45° field of view · 2352x1568 · color fundus photograph.
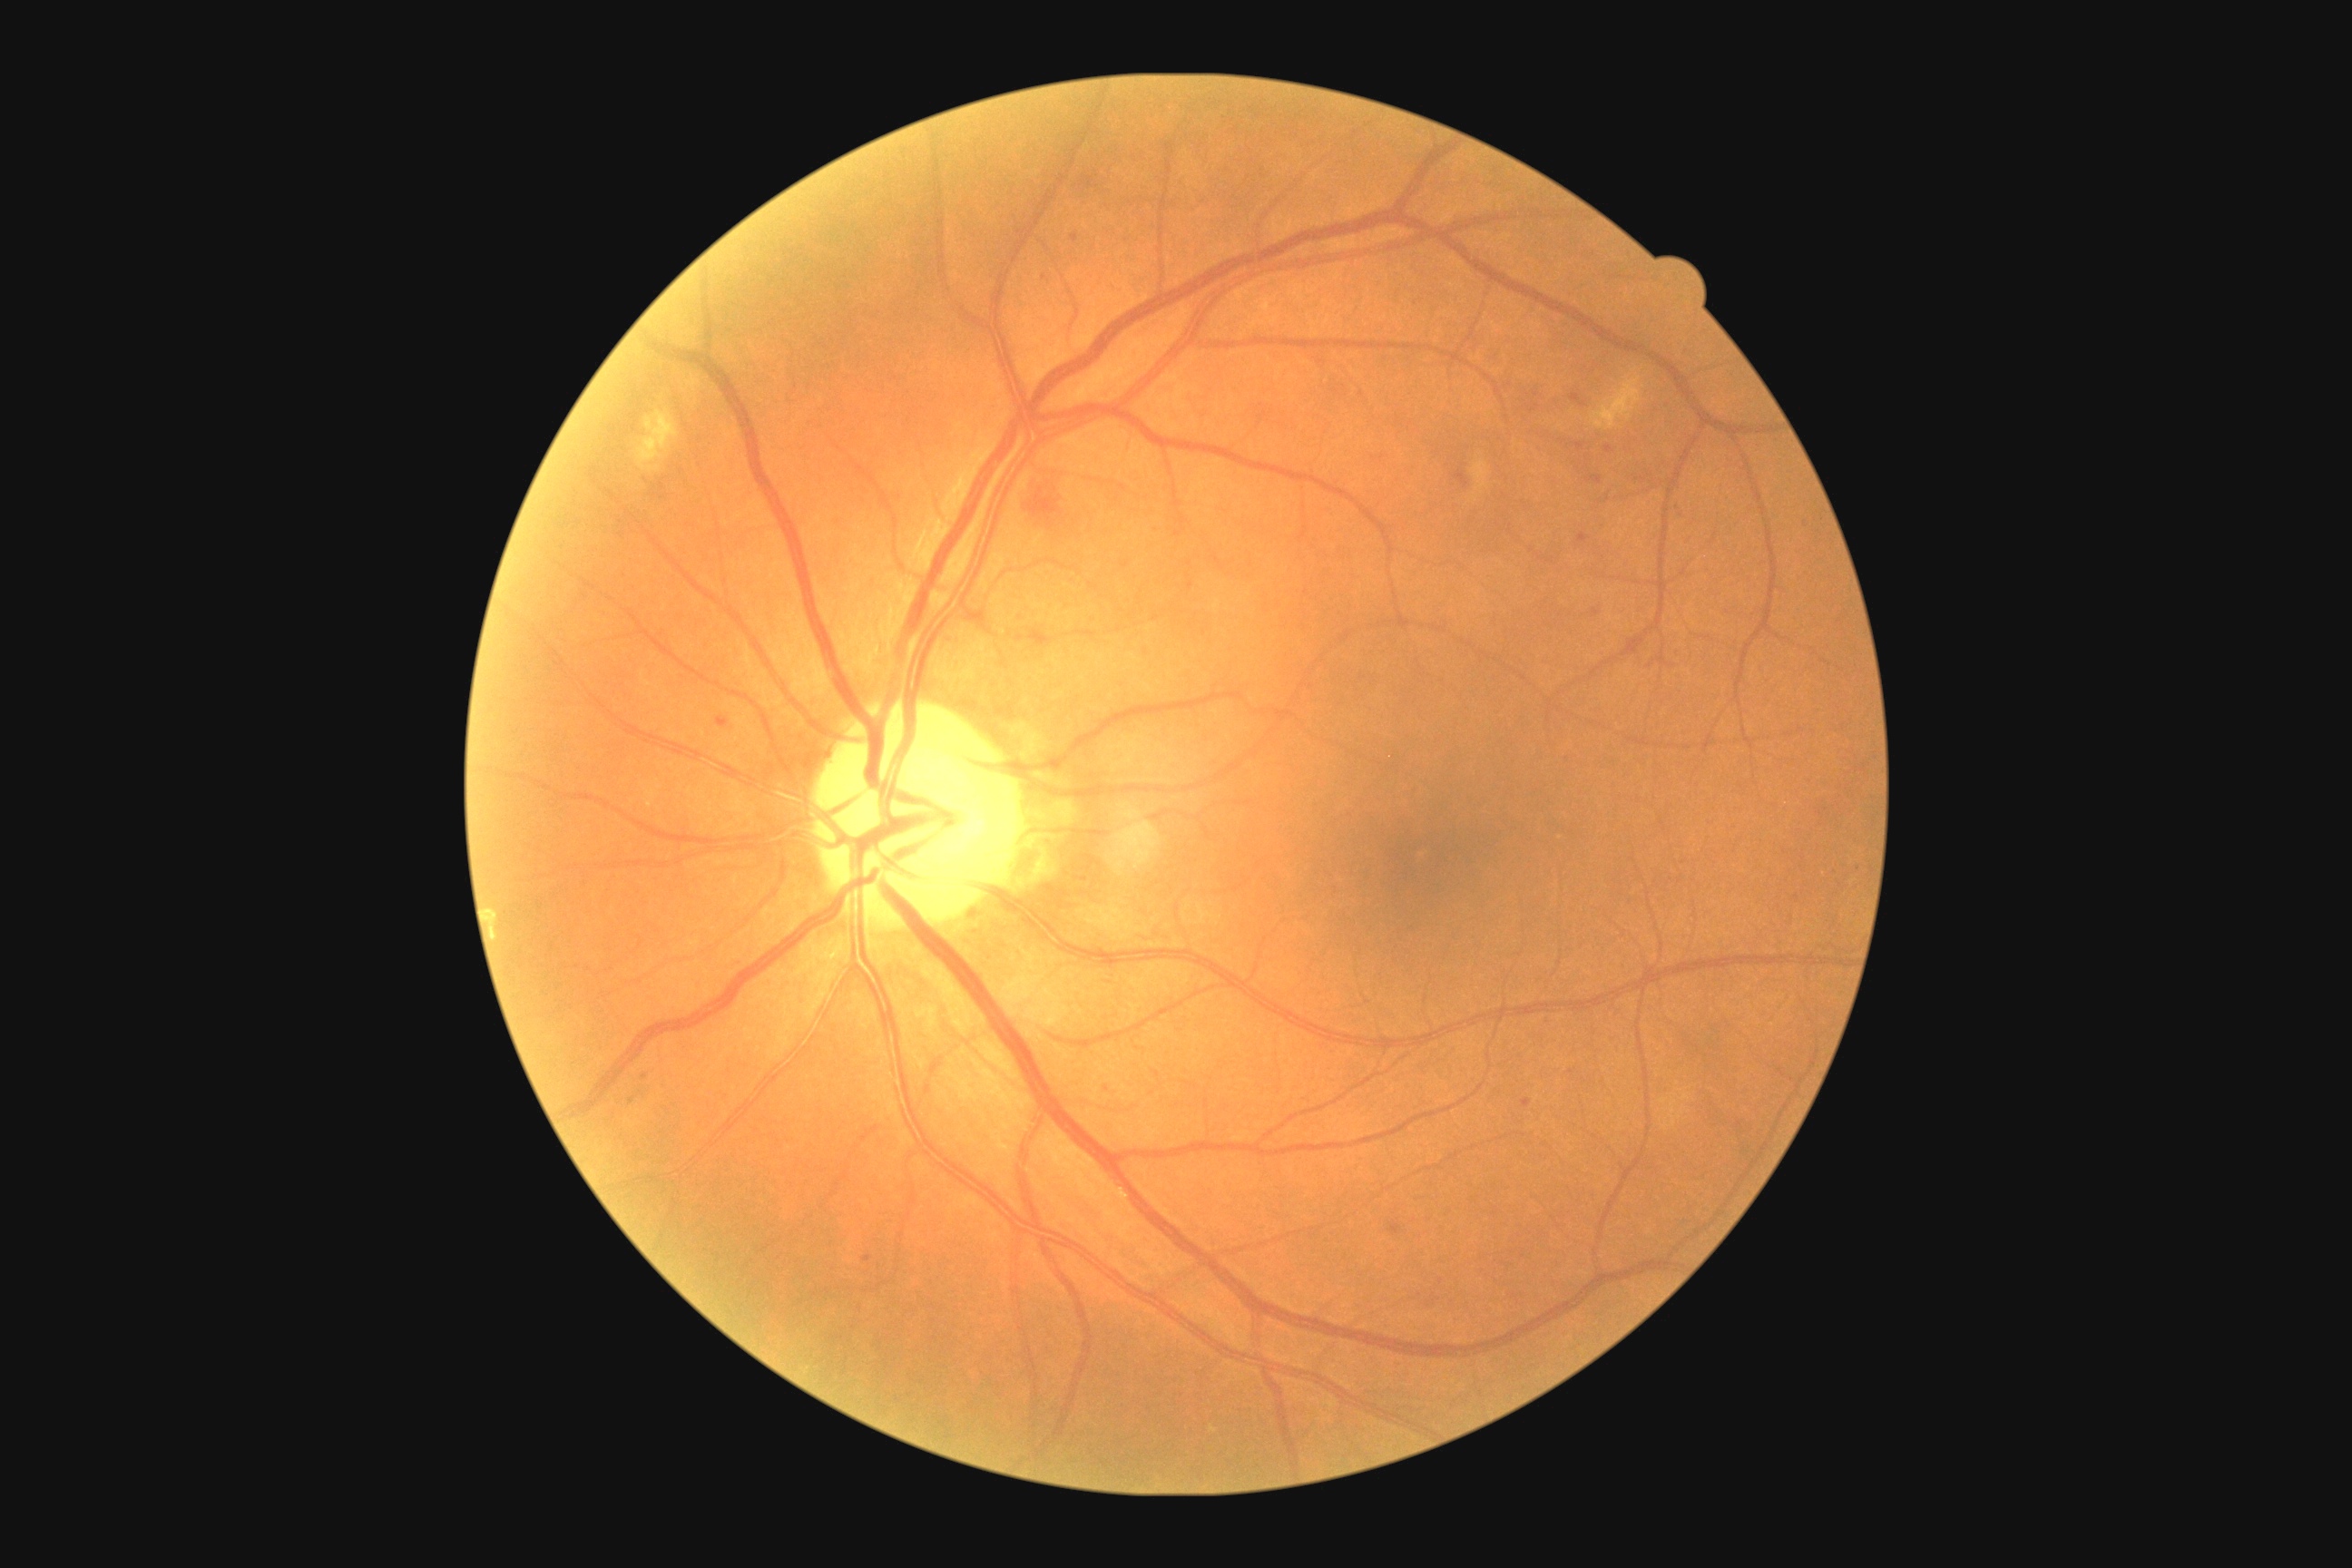   dr_grade: 2